Wide-field fundus image from infant ROP screening · 1240x1240px
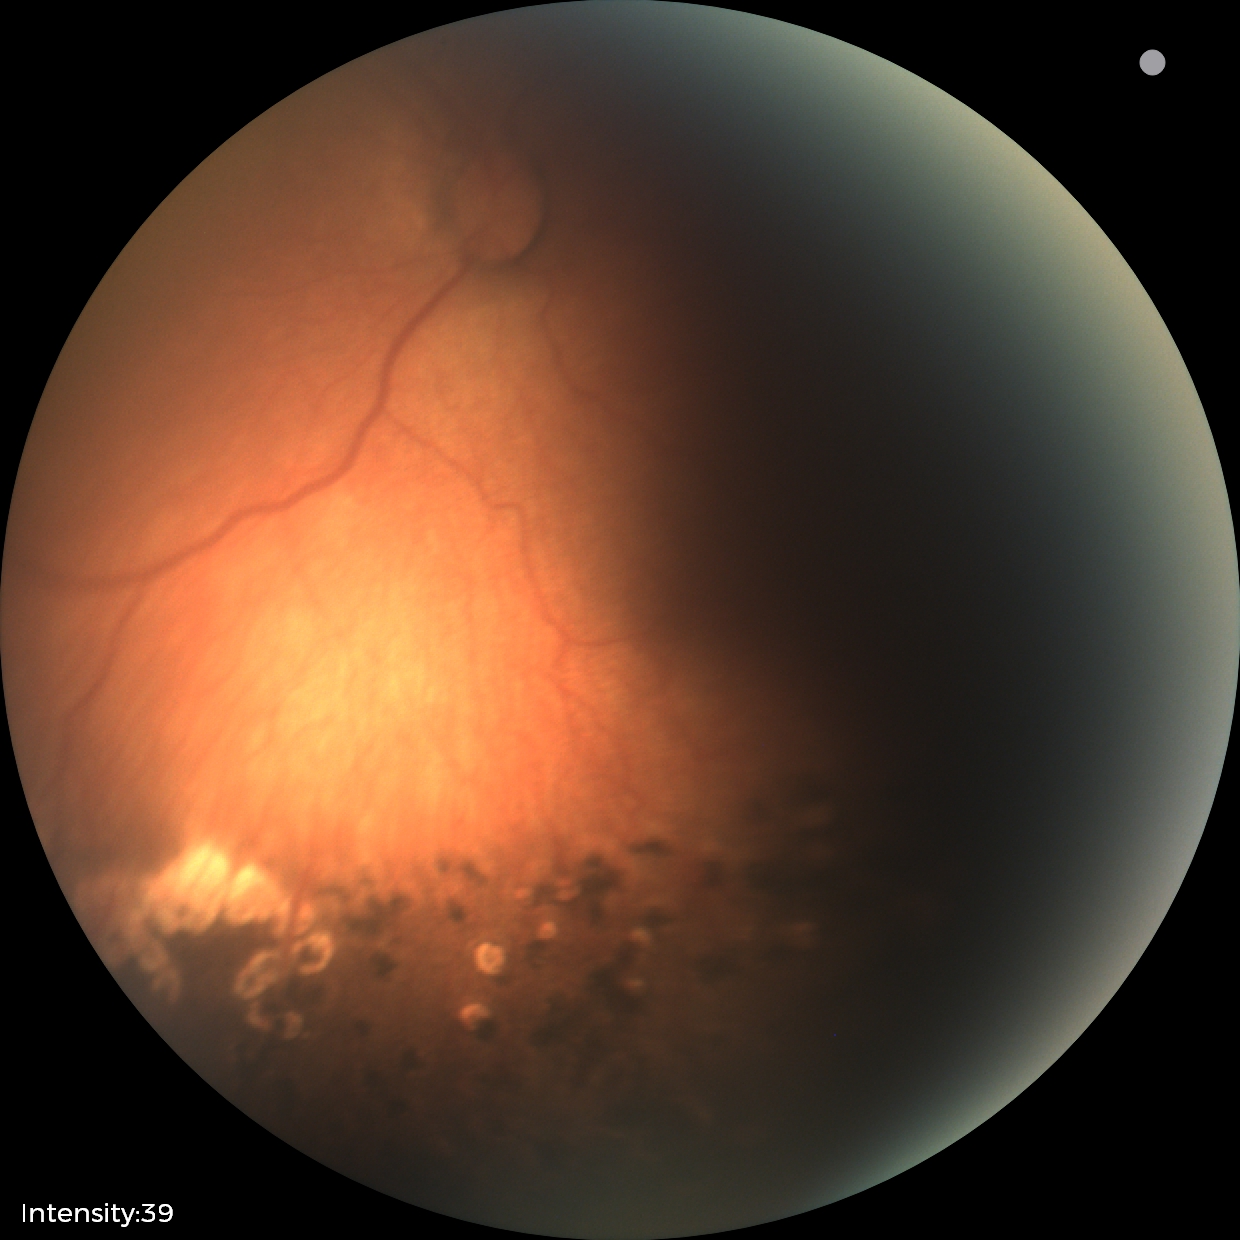

Diagnosis from this screening exam: status post retinopathy of prematurity. Plus disease absent.